Phoenix ICON wide-field infant fundus image
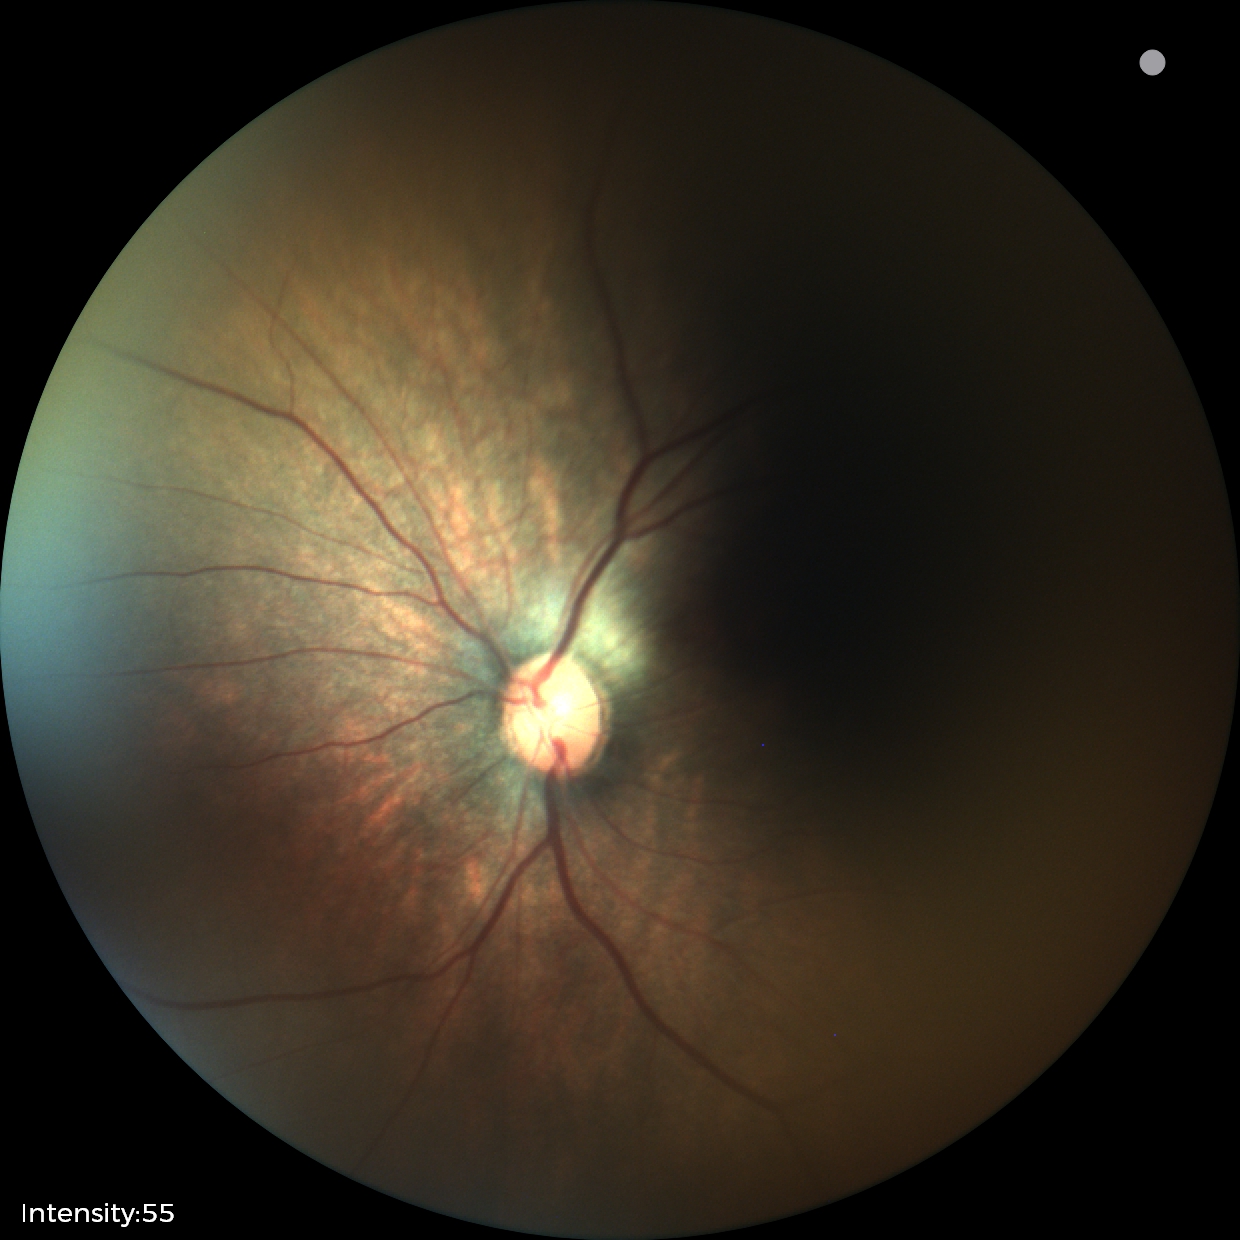

Normal screening examination.